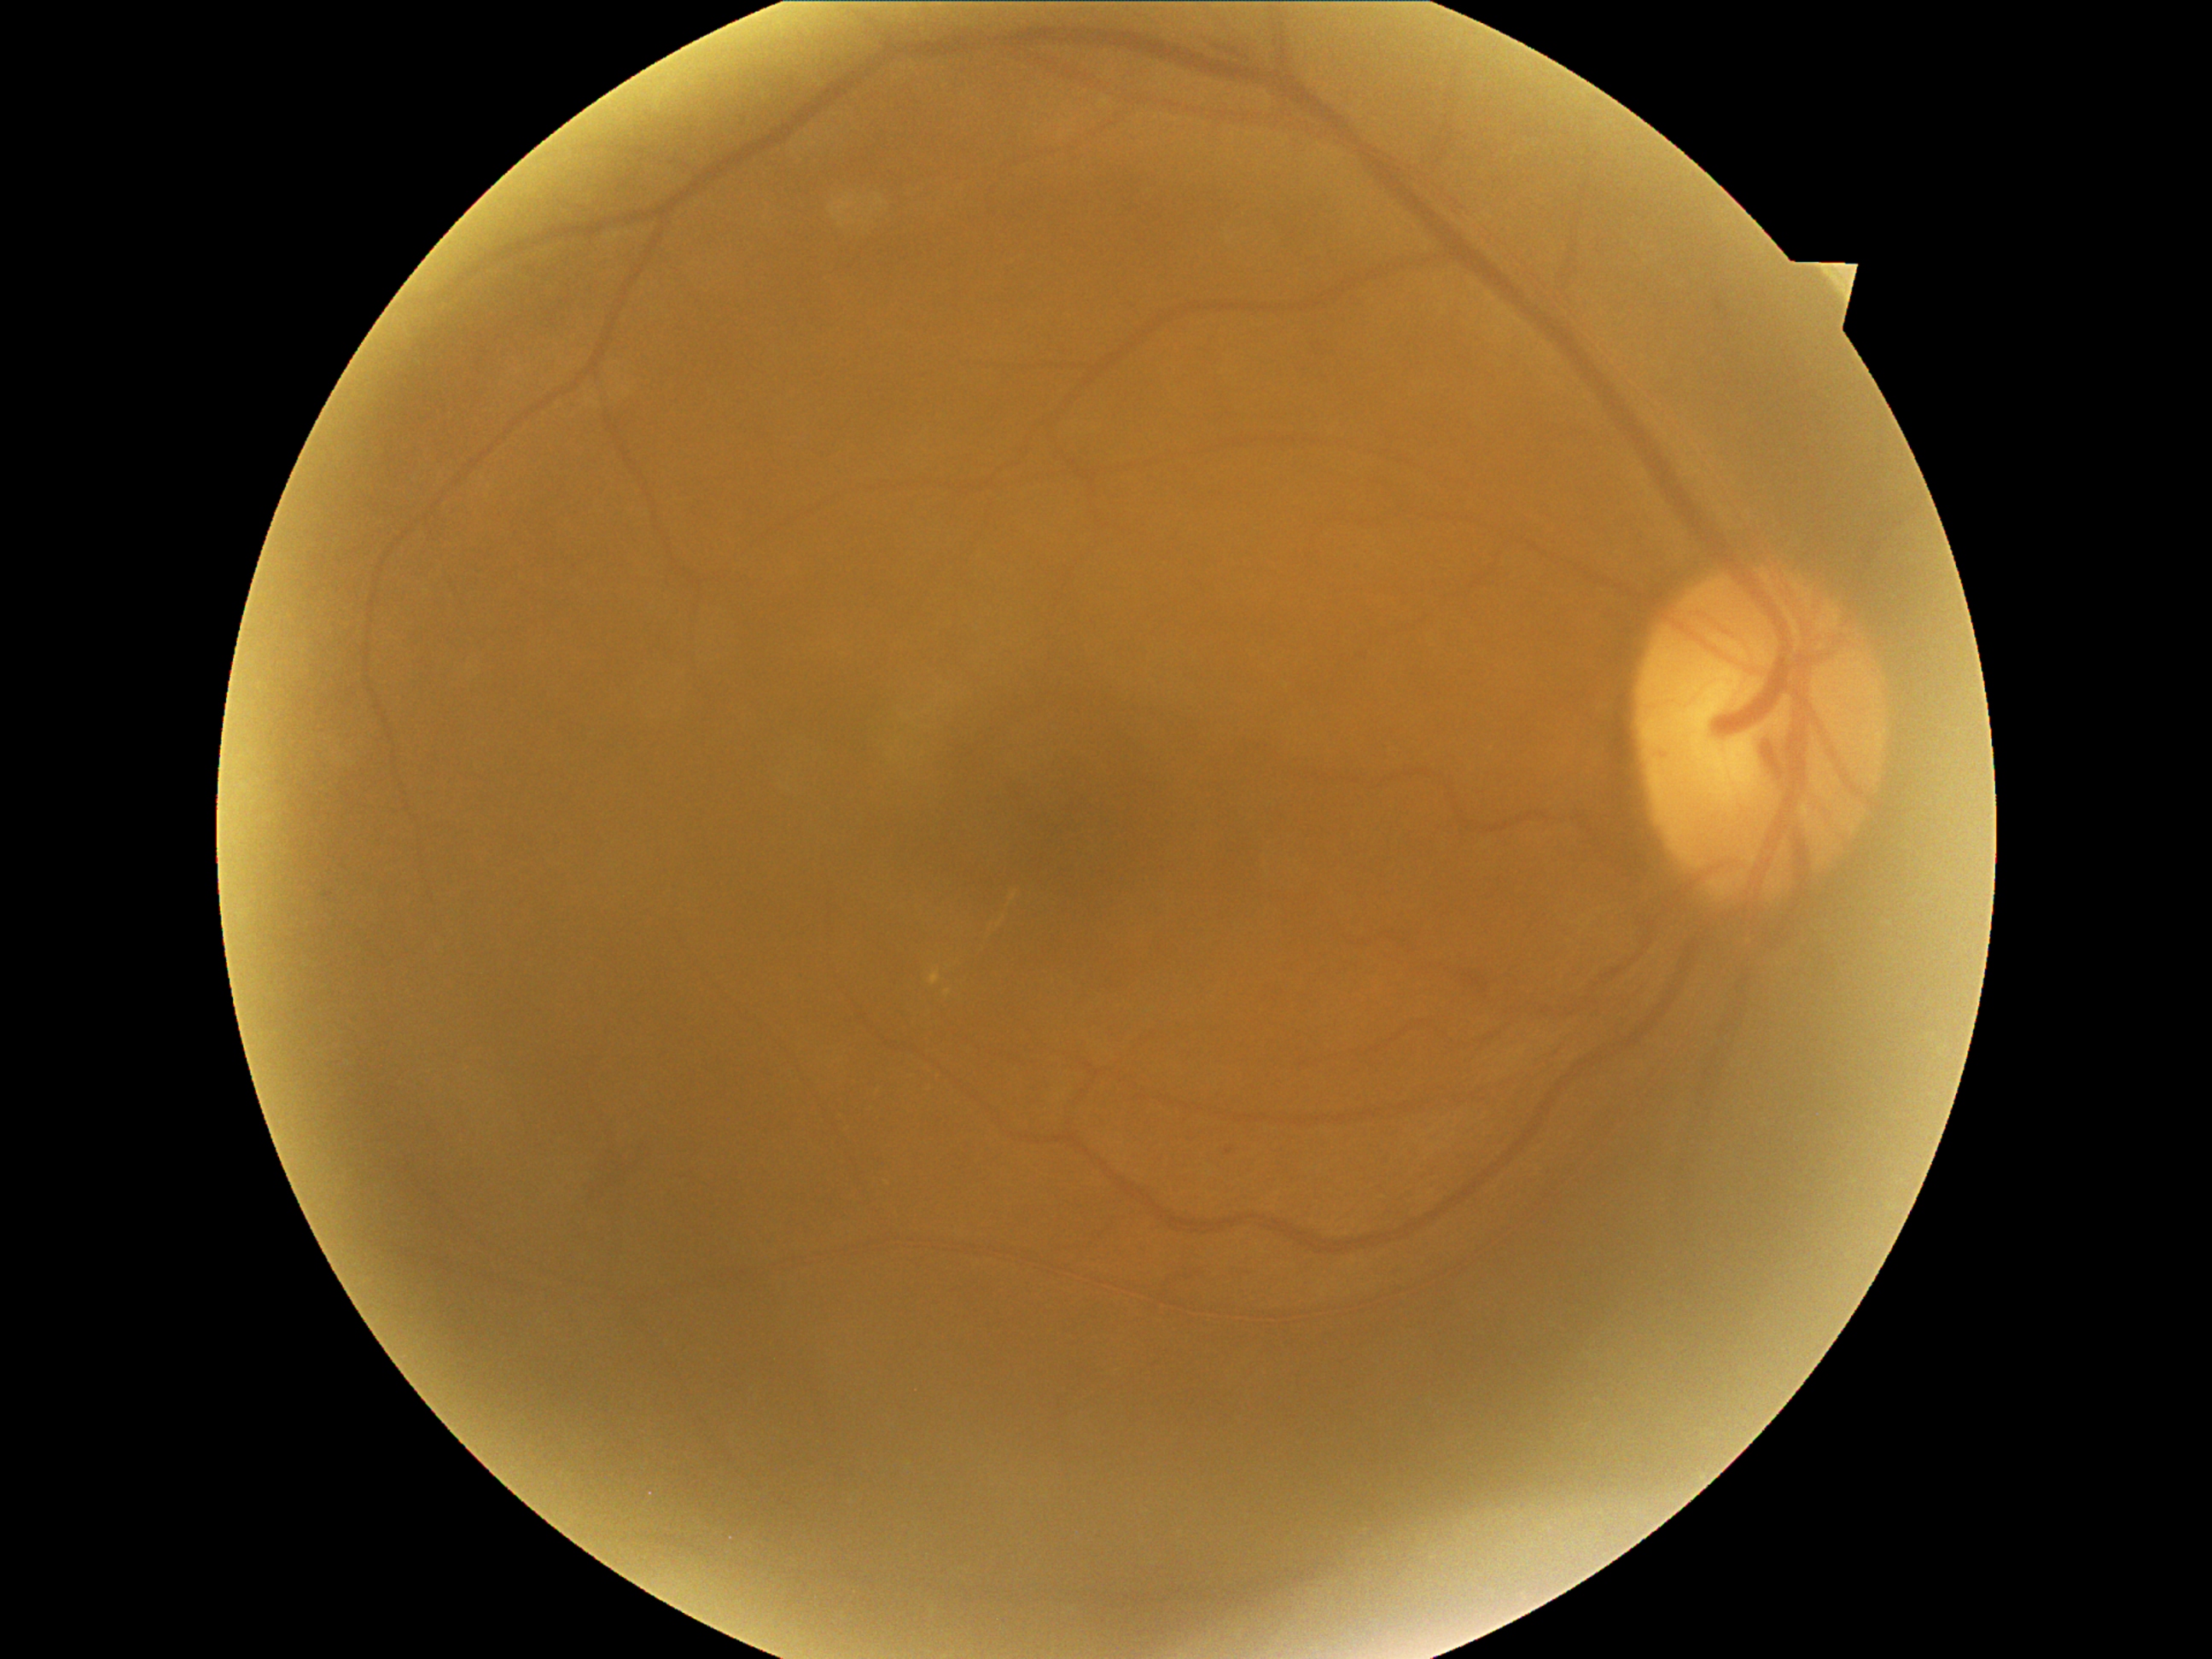 dr_grade: 2 (moderate NPDR)